Acquired with a NIDEK AFC-230 · diabetic retinopathy graded by the modified Davis classification.
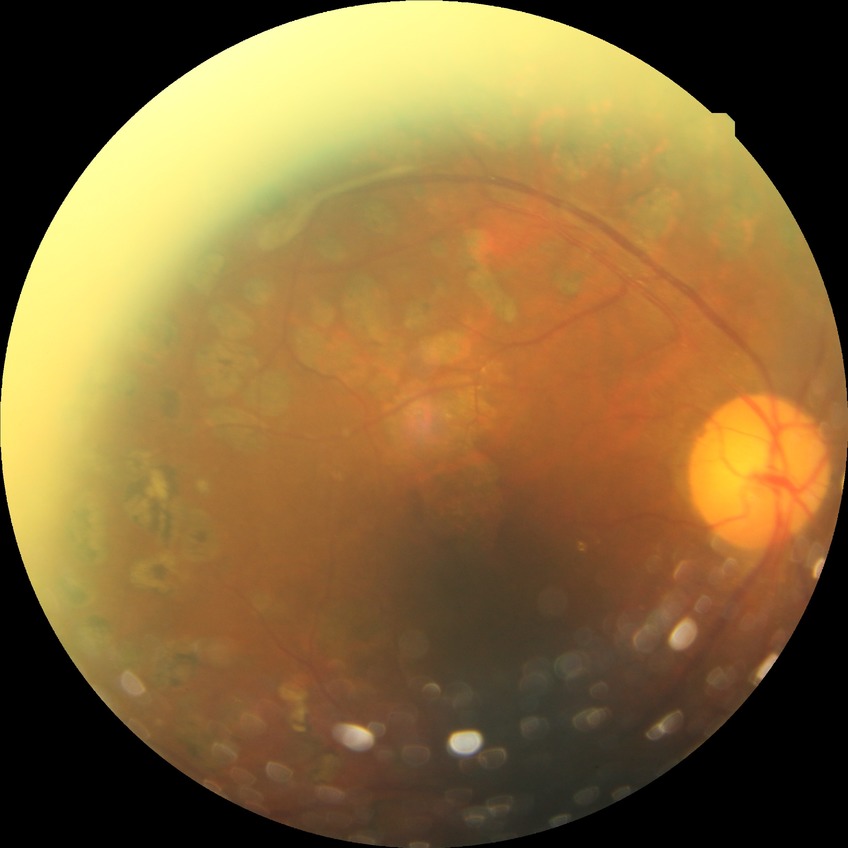

Diabetic retinopathy (DR) is PDR (proliferative diabetic retinopathy).